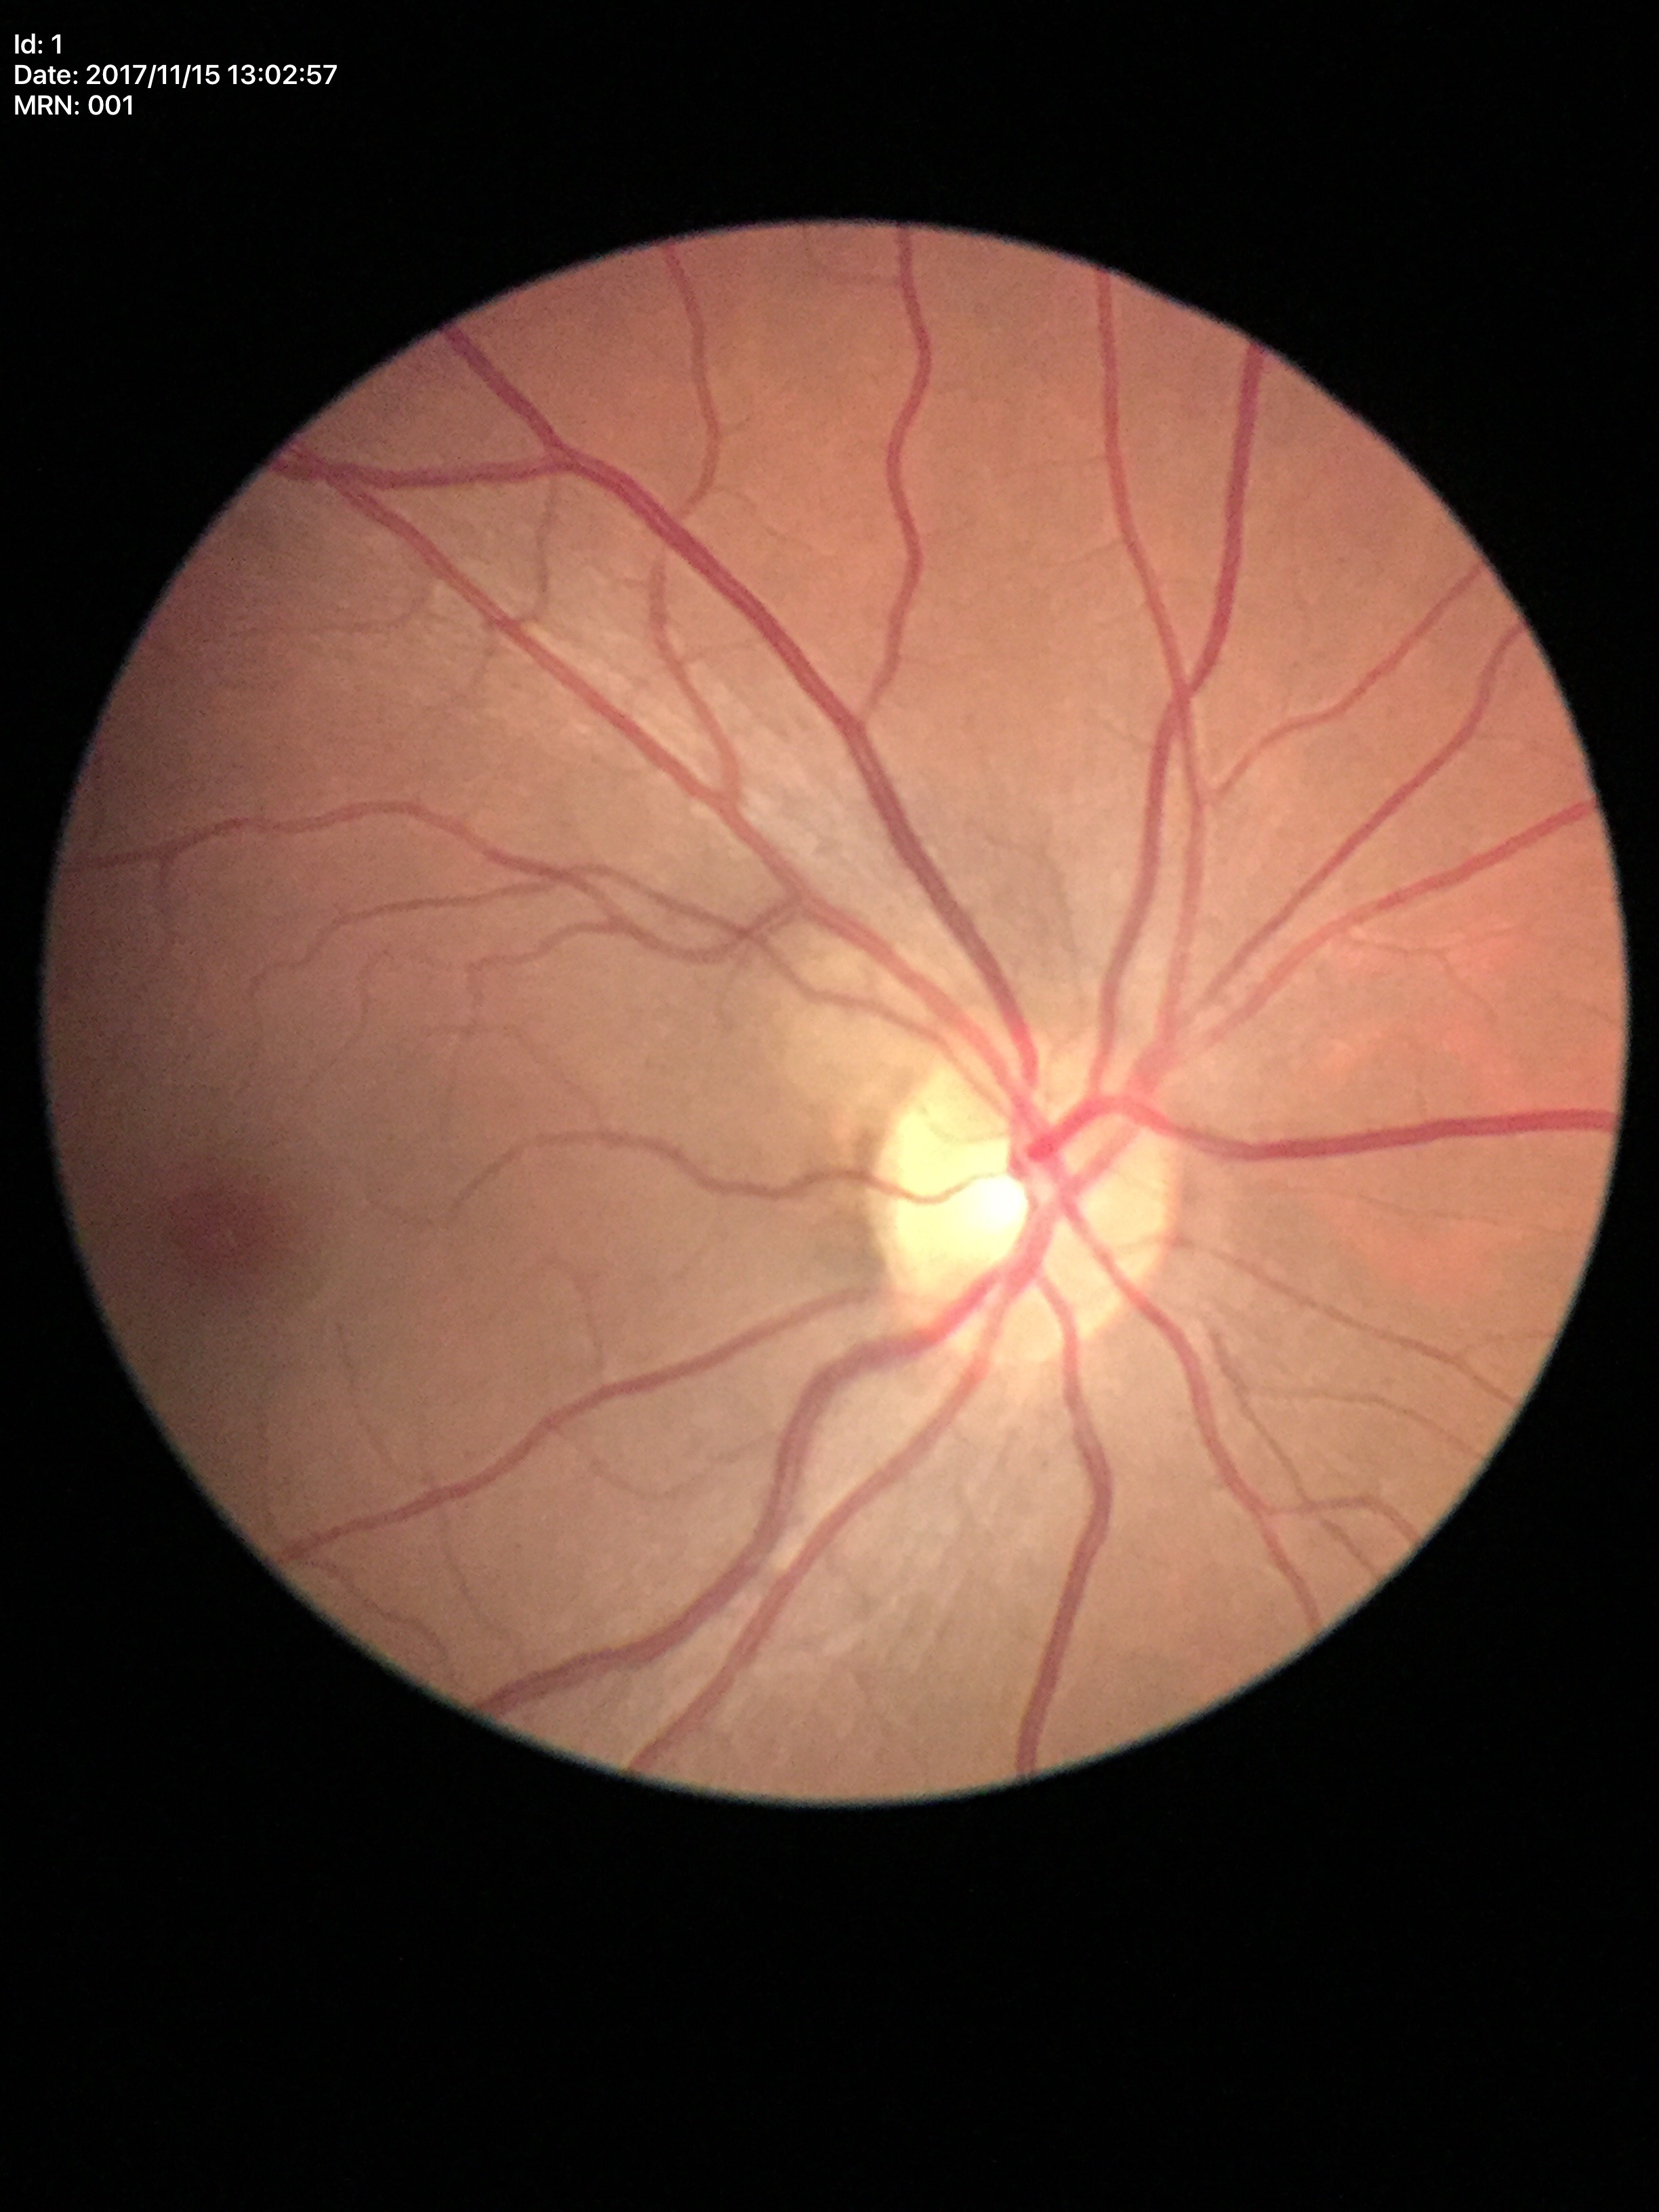

  glaucoma_decision: negative
  hcdr: 0.49
  vcdr: 0.48